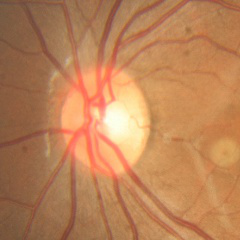

Diagnosis = no evidence of glaucoma.